848 x 848 pixels, 45° FOV, without pupil dilation, CFP, NIDEK AFC-230
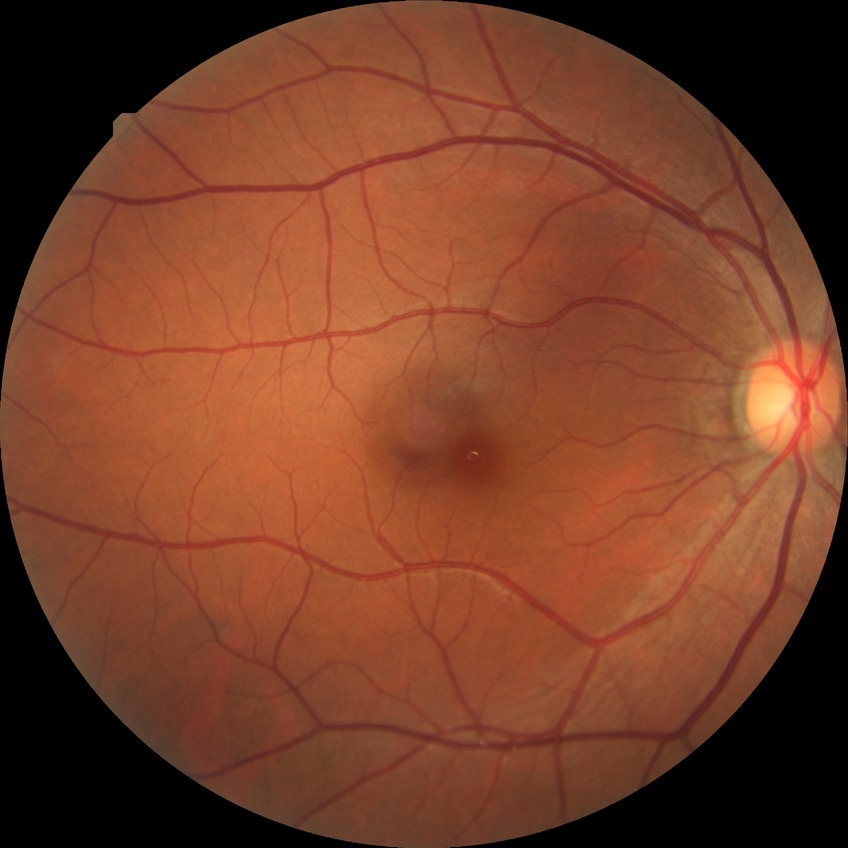
Assessment:
- DR severity — NDR